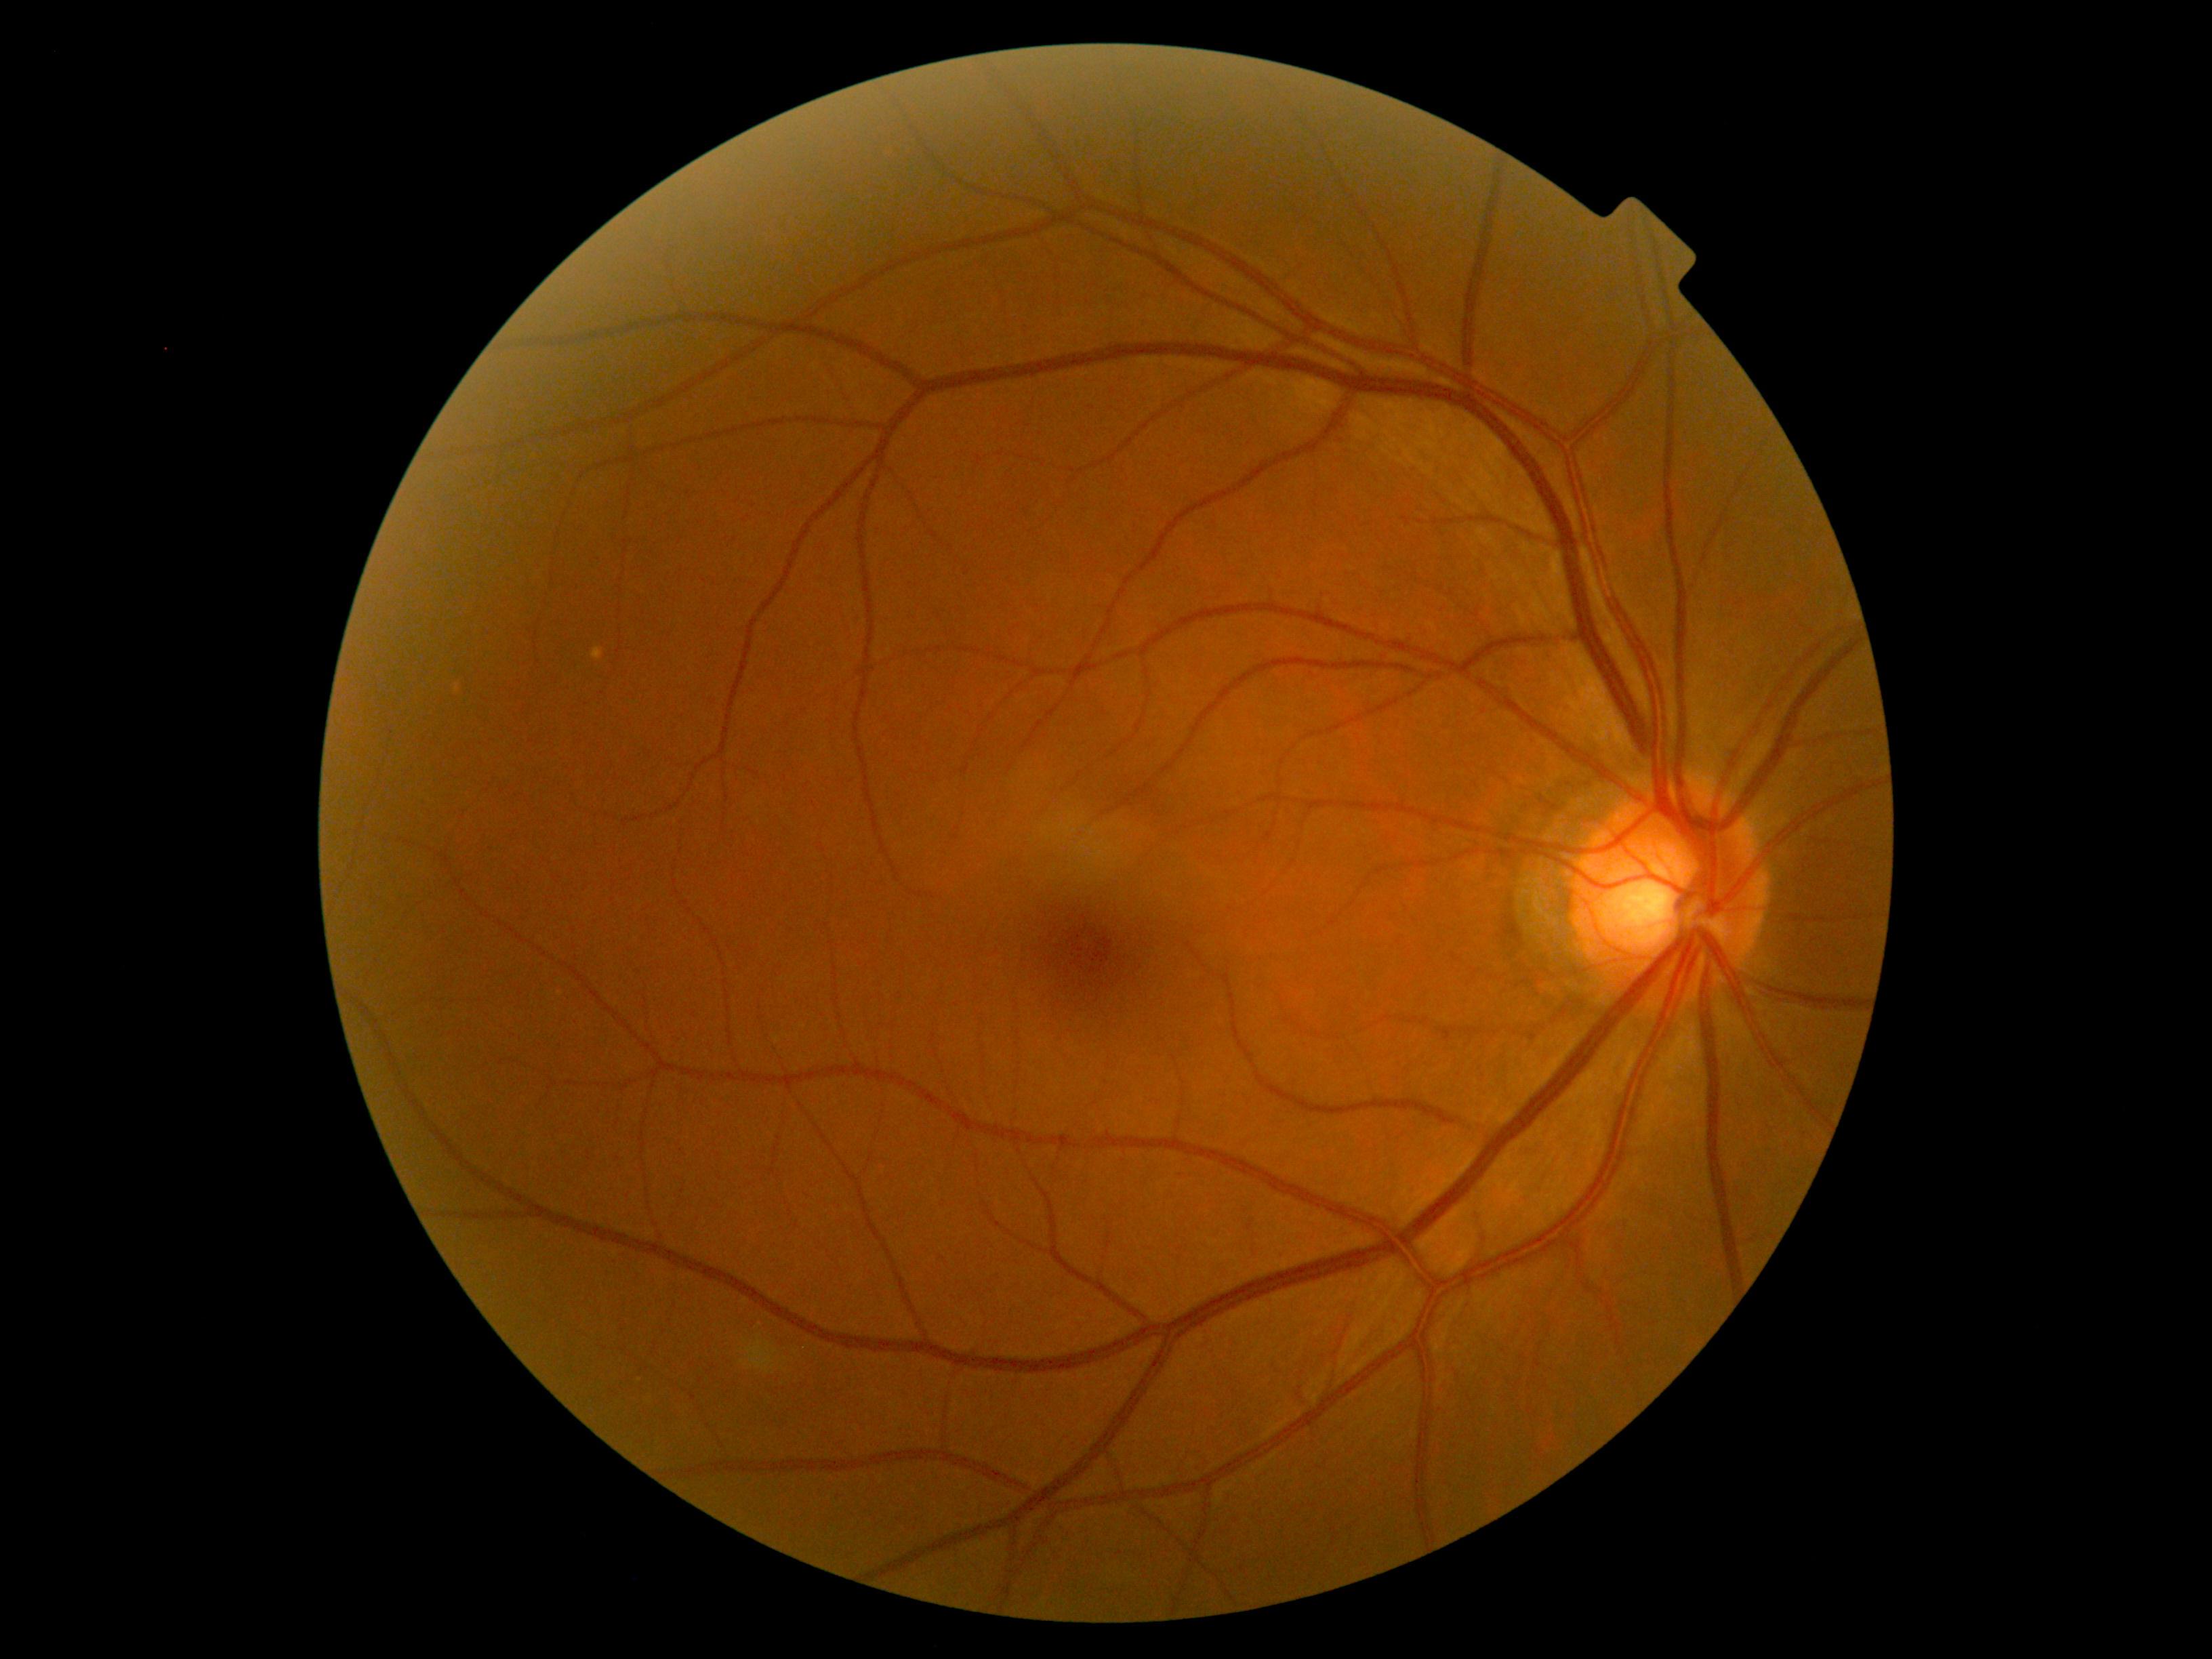
DR grade is 0 (no apparent retinopathy) — no visible signs of diabetic retinopathy.